45 degree fundus photograph, posterior pole color fundus photograph, without pupil dilation, DR severity per modified Davis staging, image size 848x848, camera: NIDEK AFC-230 — 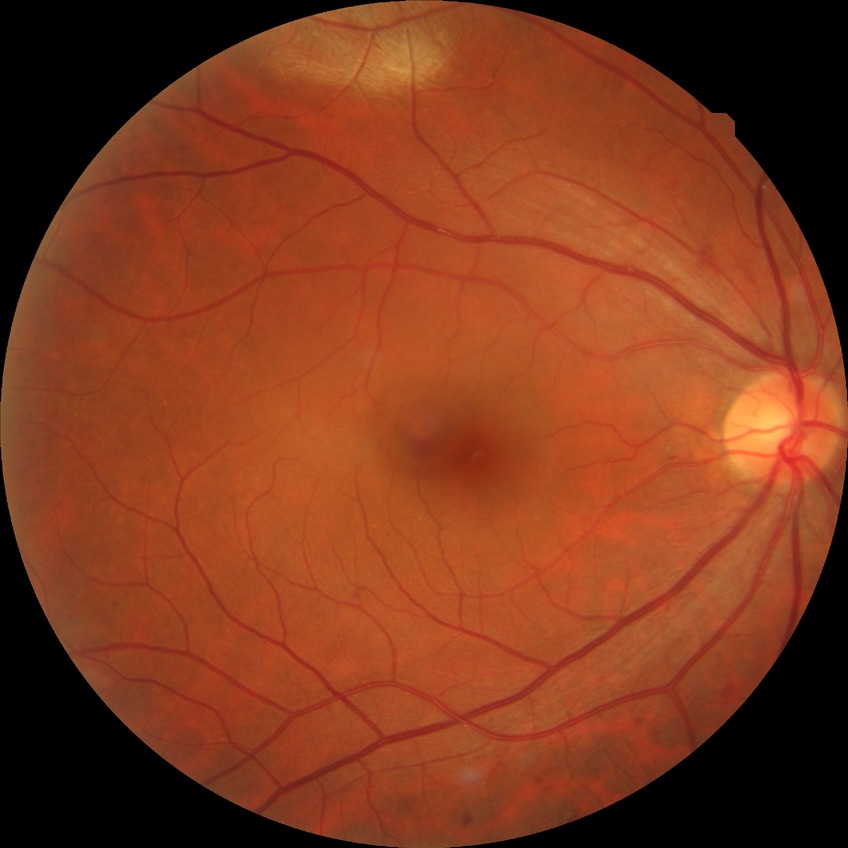
DR class: non-proliferative diabetic retinopathy.
Diabetic retinopathy (DR): simple diabetic retinopathy (SDR).